Diabetic retinopathy graded by the modified Davis classification
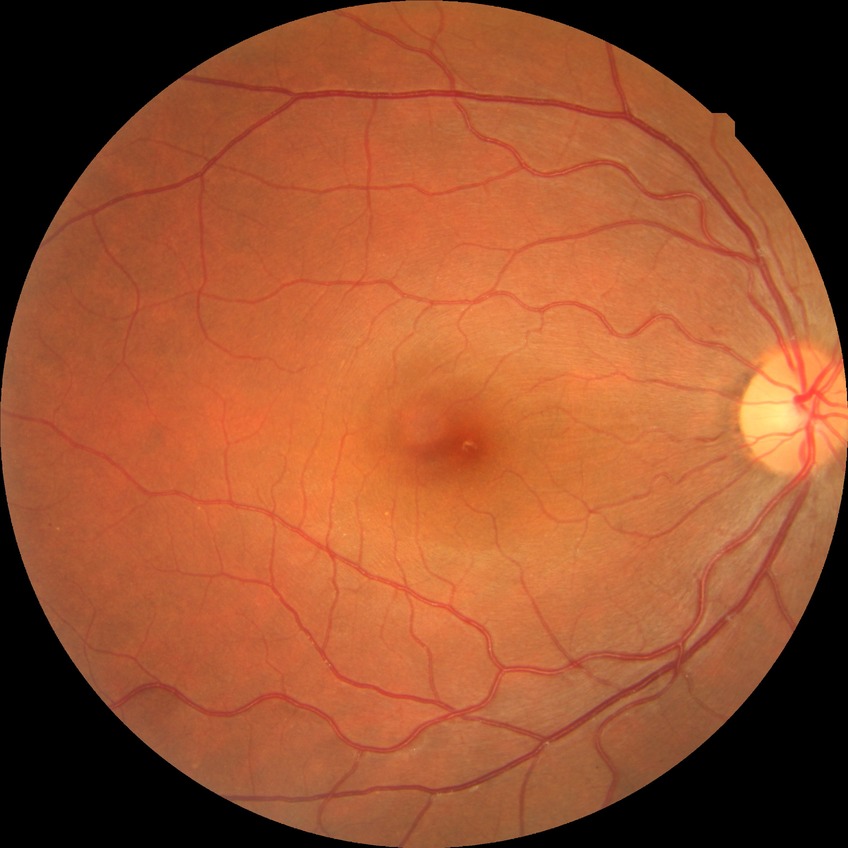
DR stage is NDR.